Wide-field fundus image from infant ROP screening.
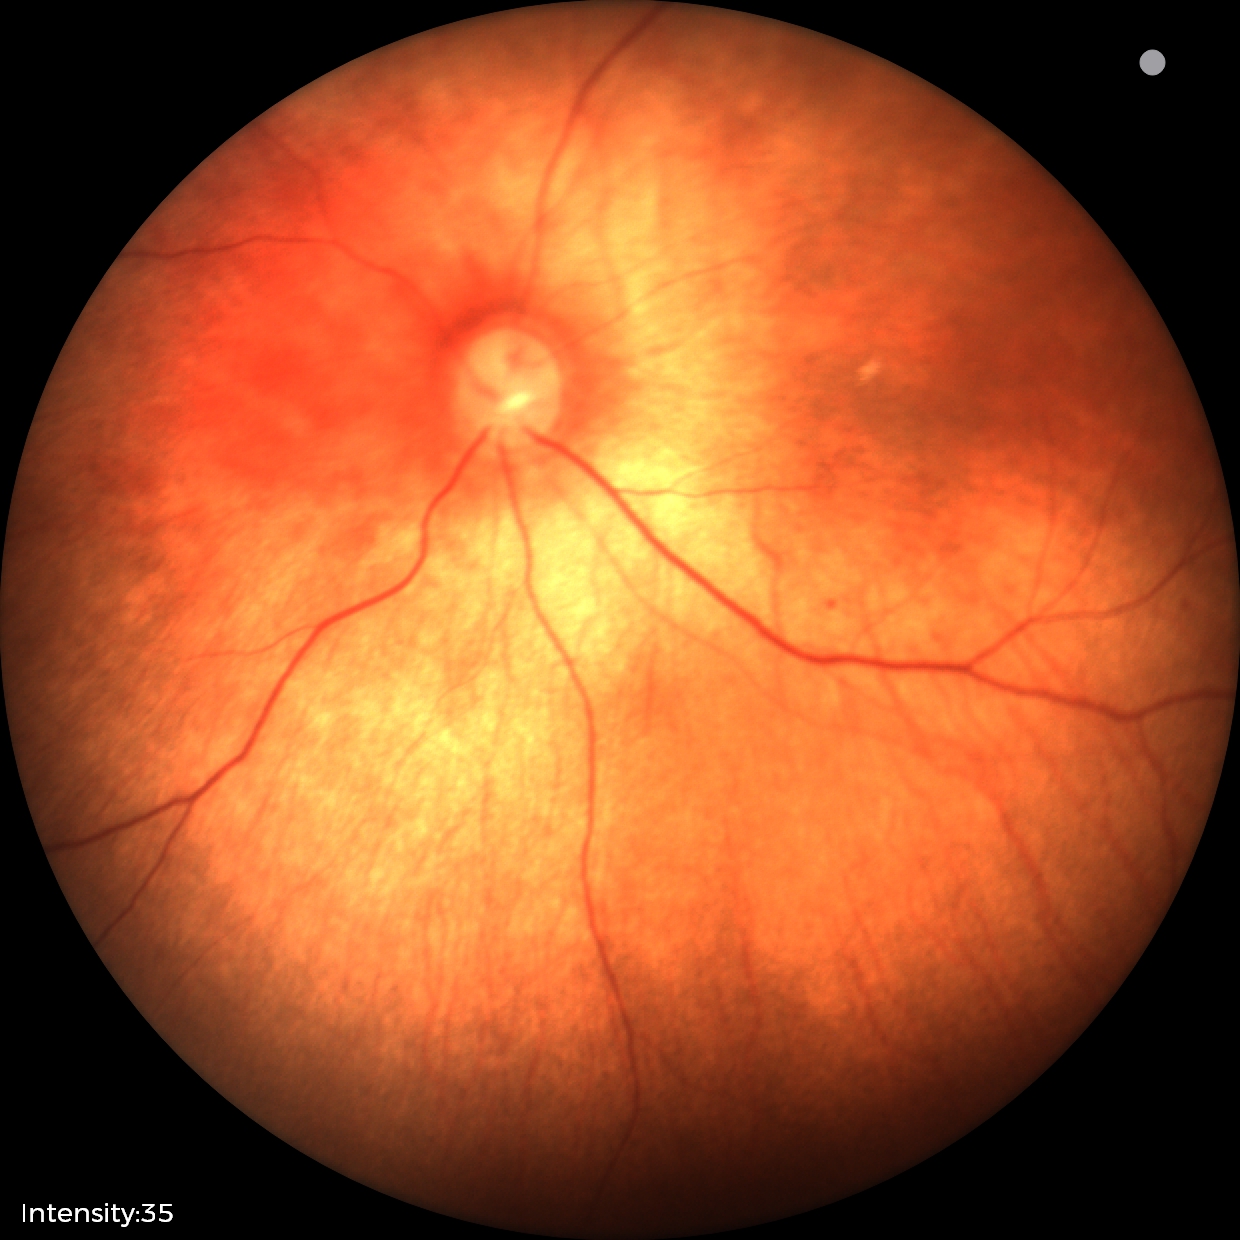
Screening examination with no abnormal retinal findings.